Modified Davis grading: 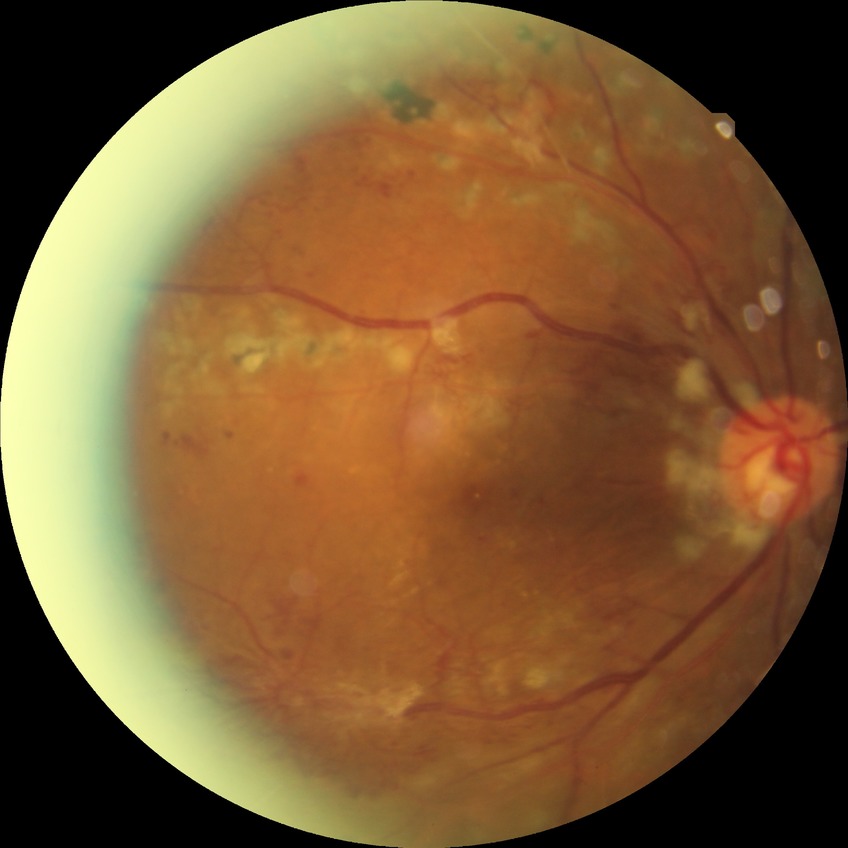

diabetic retinopathy (DR) = proliferative diabetic retinopathy (PDR).